45 degree fundus photograph: 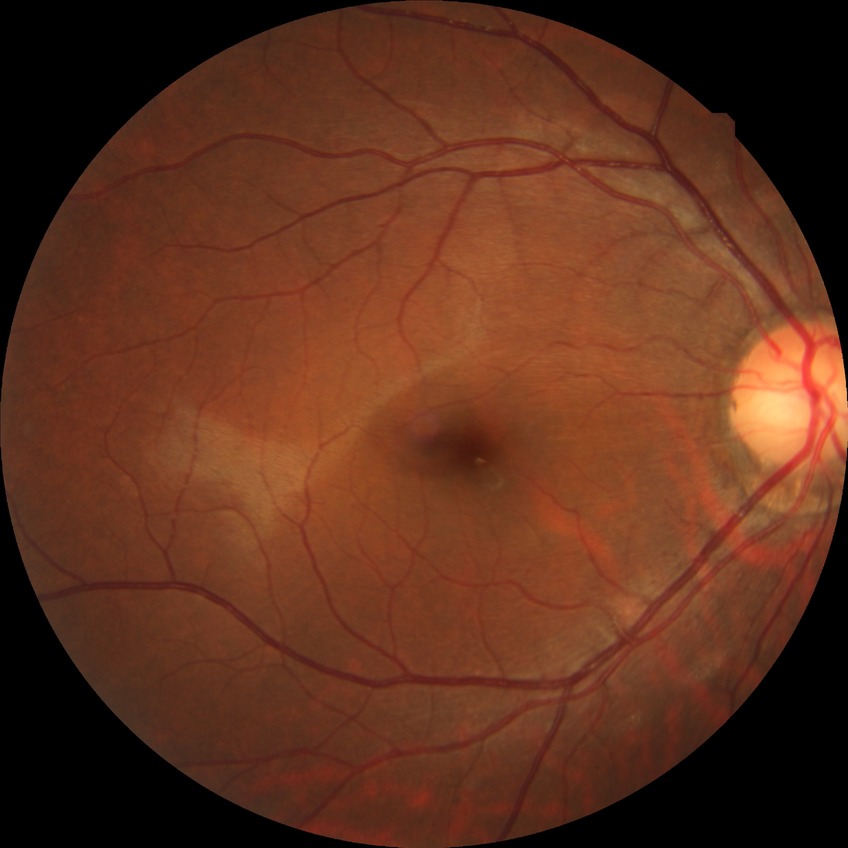   davis_grade: no diabetic retinopathy